Pediatric retinal photograph (wide-field). Clarity RetCam 3, 130° FOV
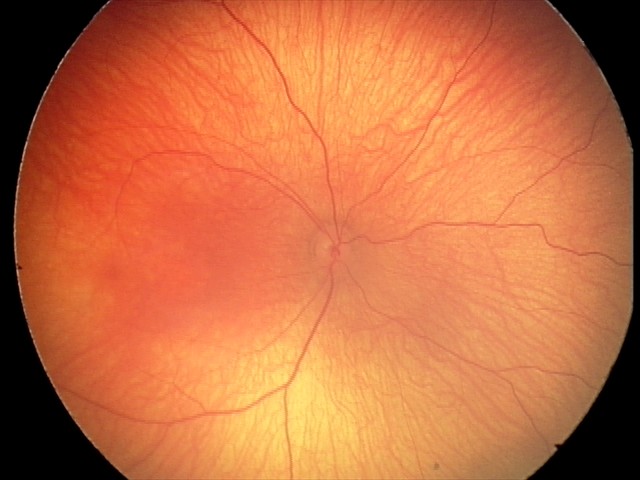 Impression: no abnormalities.